Pediatric retinal photograph (wide-field)
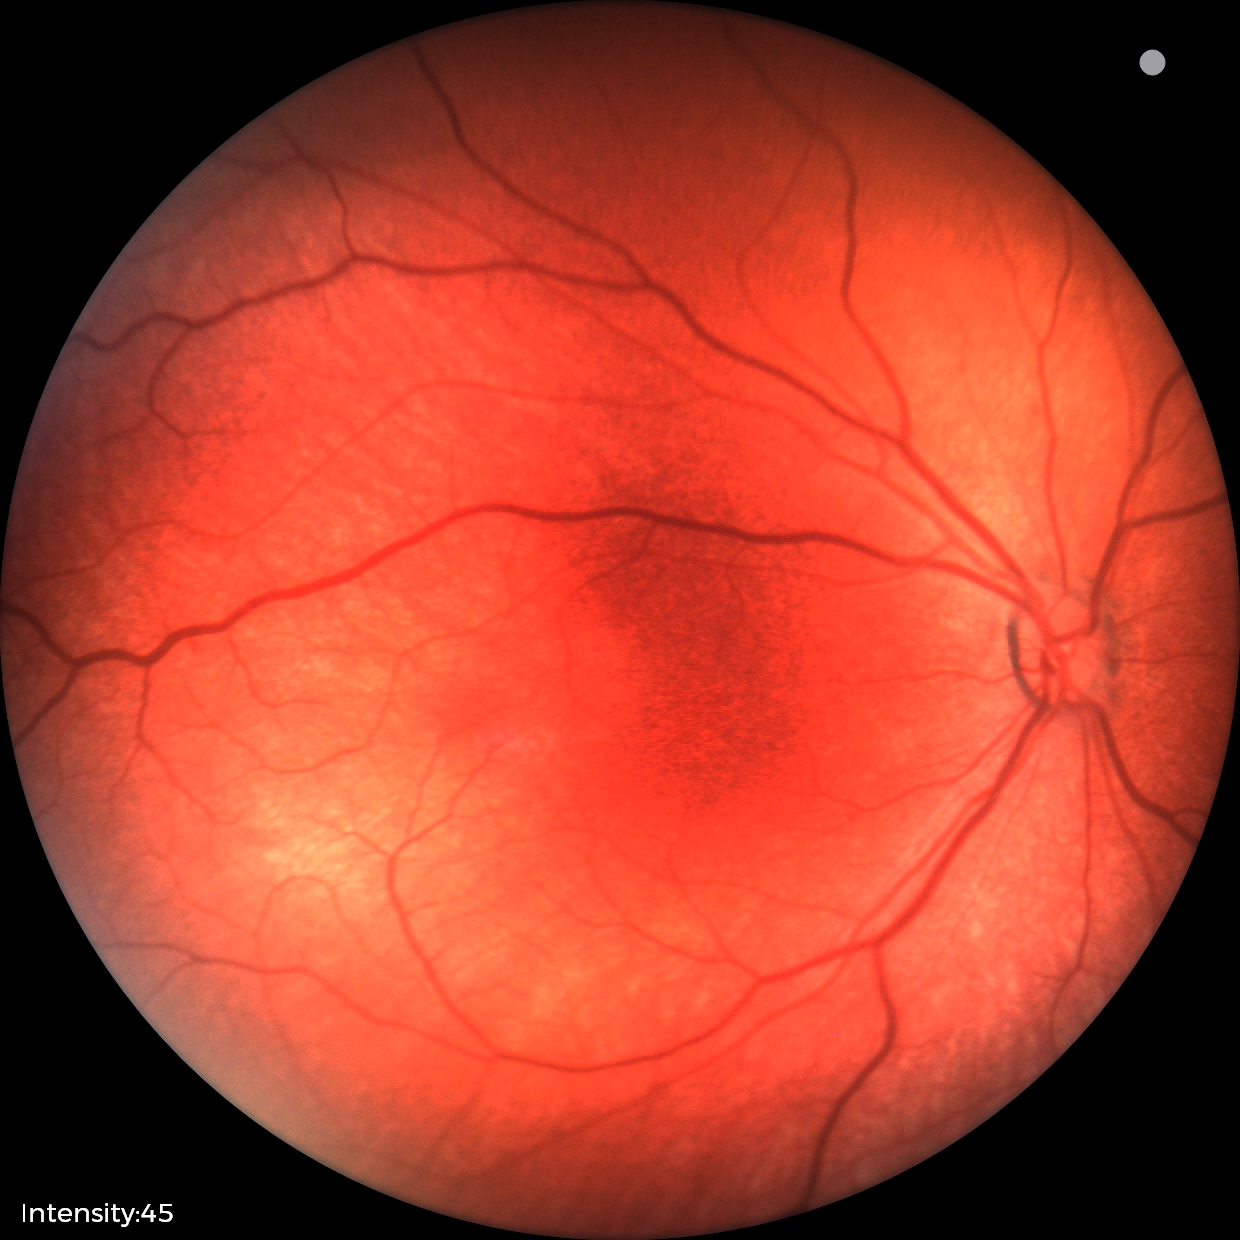

Q: What is the diagnosis from this examination?
A: normal retinal appearance